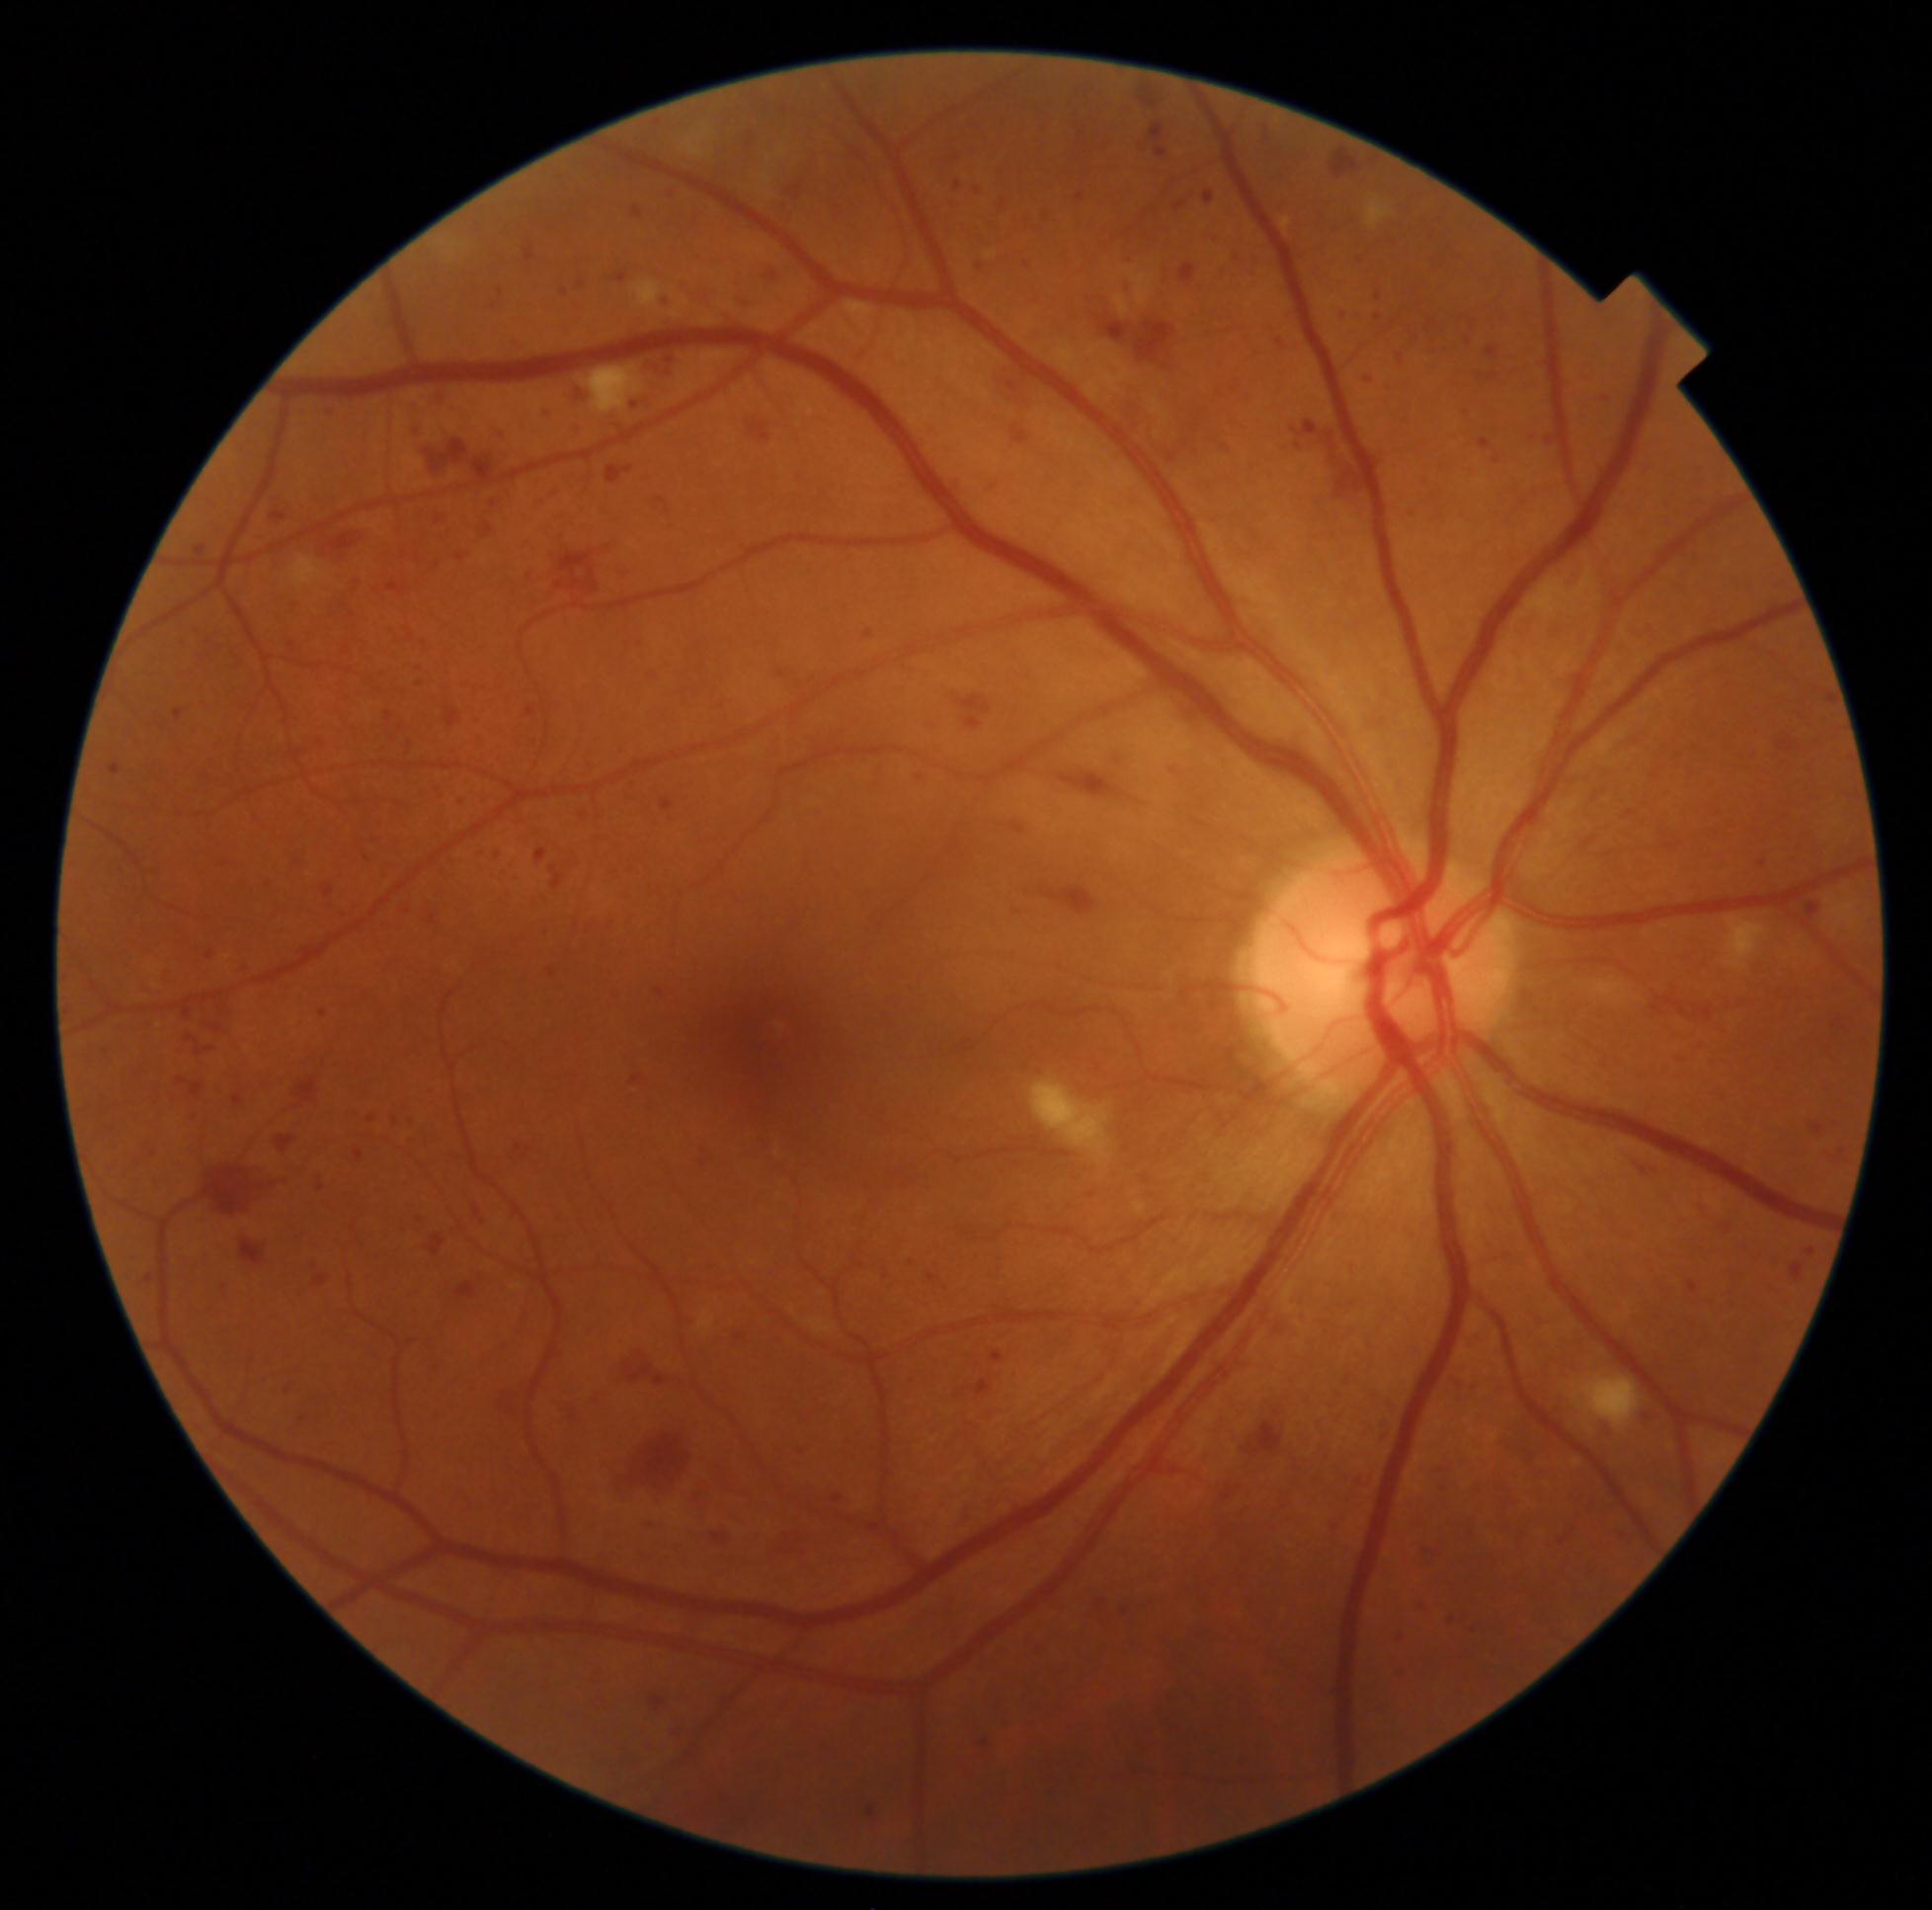

Diabetic retinopathy (DR) is severe non-proliferative diabetic retinopathy (grade 3). No microaneurysms (MAs) identified. Soft exudates (SEs) at <box>684,130,711,160</box> | <box>1030,1079,1112,1163</box> | <box>582,367,645,416</box> | <box>1725,916,1769,972</box> | <box>698,1311,716,1330</box> | <box>1366,196,1391,230</box> | <box>1573,1375,1641,1432</box> | <box>291,556,329,594</box> | <box>630,278,666,308</box>. Hemorrhages (HEs) include <box>541,927,554,938</box> | <box>369,1188,384,1199</box> | <box>491,847,504,861</box> | <box>657,295,677,310</box> | <box>535,406,554,423</box> | <box>1377,1414,1398,1441</box> | <box>767,1334,787,1348</box> | <box>291,1074,323,1108</box> | <box>475,847,486,858</box> | <box>1489,374,1500,381</box> | <box>1716,1218,1733,1237</box> | <box>1614,1527,1638,1547</box> | <box>409,385,532,483</box> | <box>291,1409,311,1429</box> | <box>143,1020,159,1033</box> | <box>1361,370,1377,385</box> | <box>1589,784,1614,812</box> | <box>497,1375,537,1427</box>. Small HEs near x=1452, y=1621 | x=401, y=729. Hard exudates (EXs) at <box>1282,217,1293,231</box>.